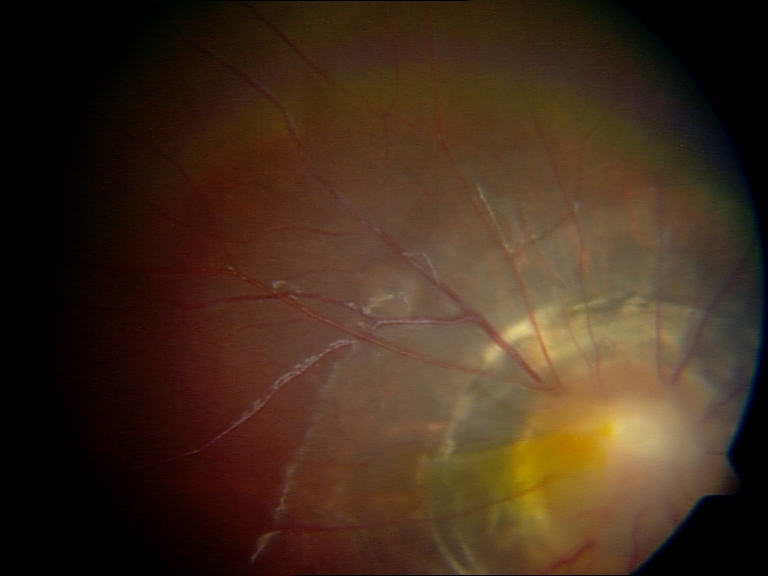
Fundus image consistent with congenital disc abnormality. Defined by optic disc coloboma, morning glory anomaly, optic pit, megalopapilla, or hypoplastic disc.